Infant wide-field fundus photograph
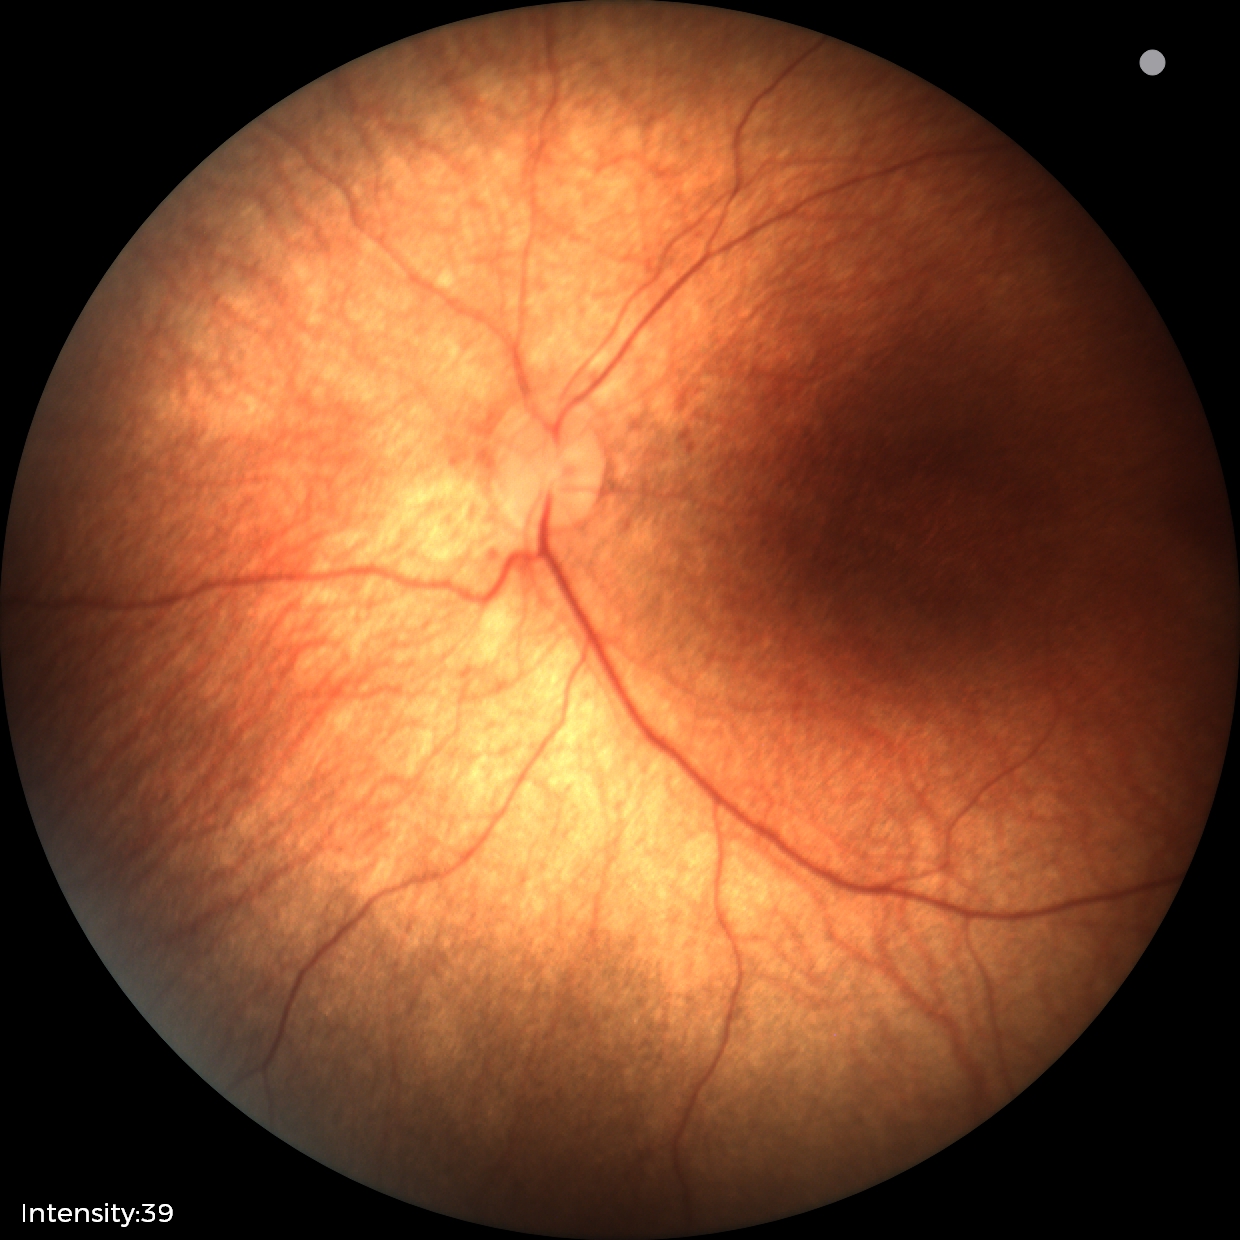
Examination with physiological retinal findings.